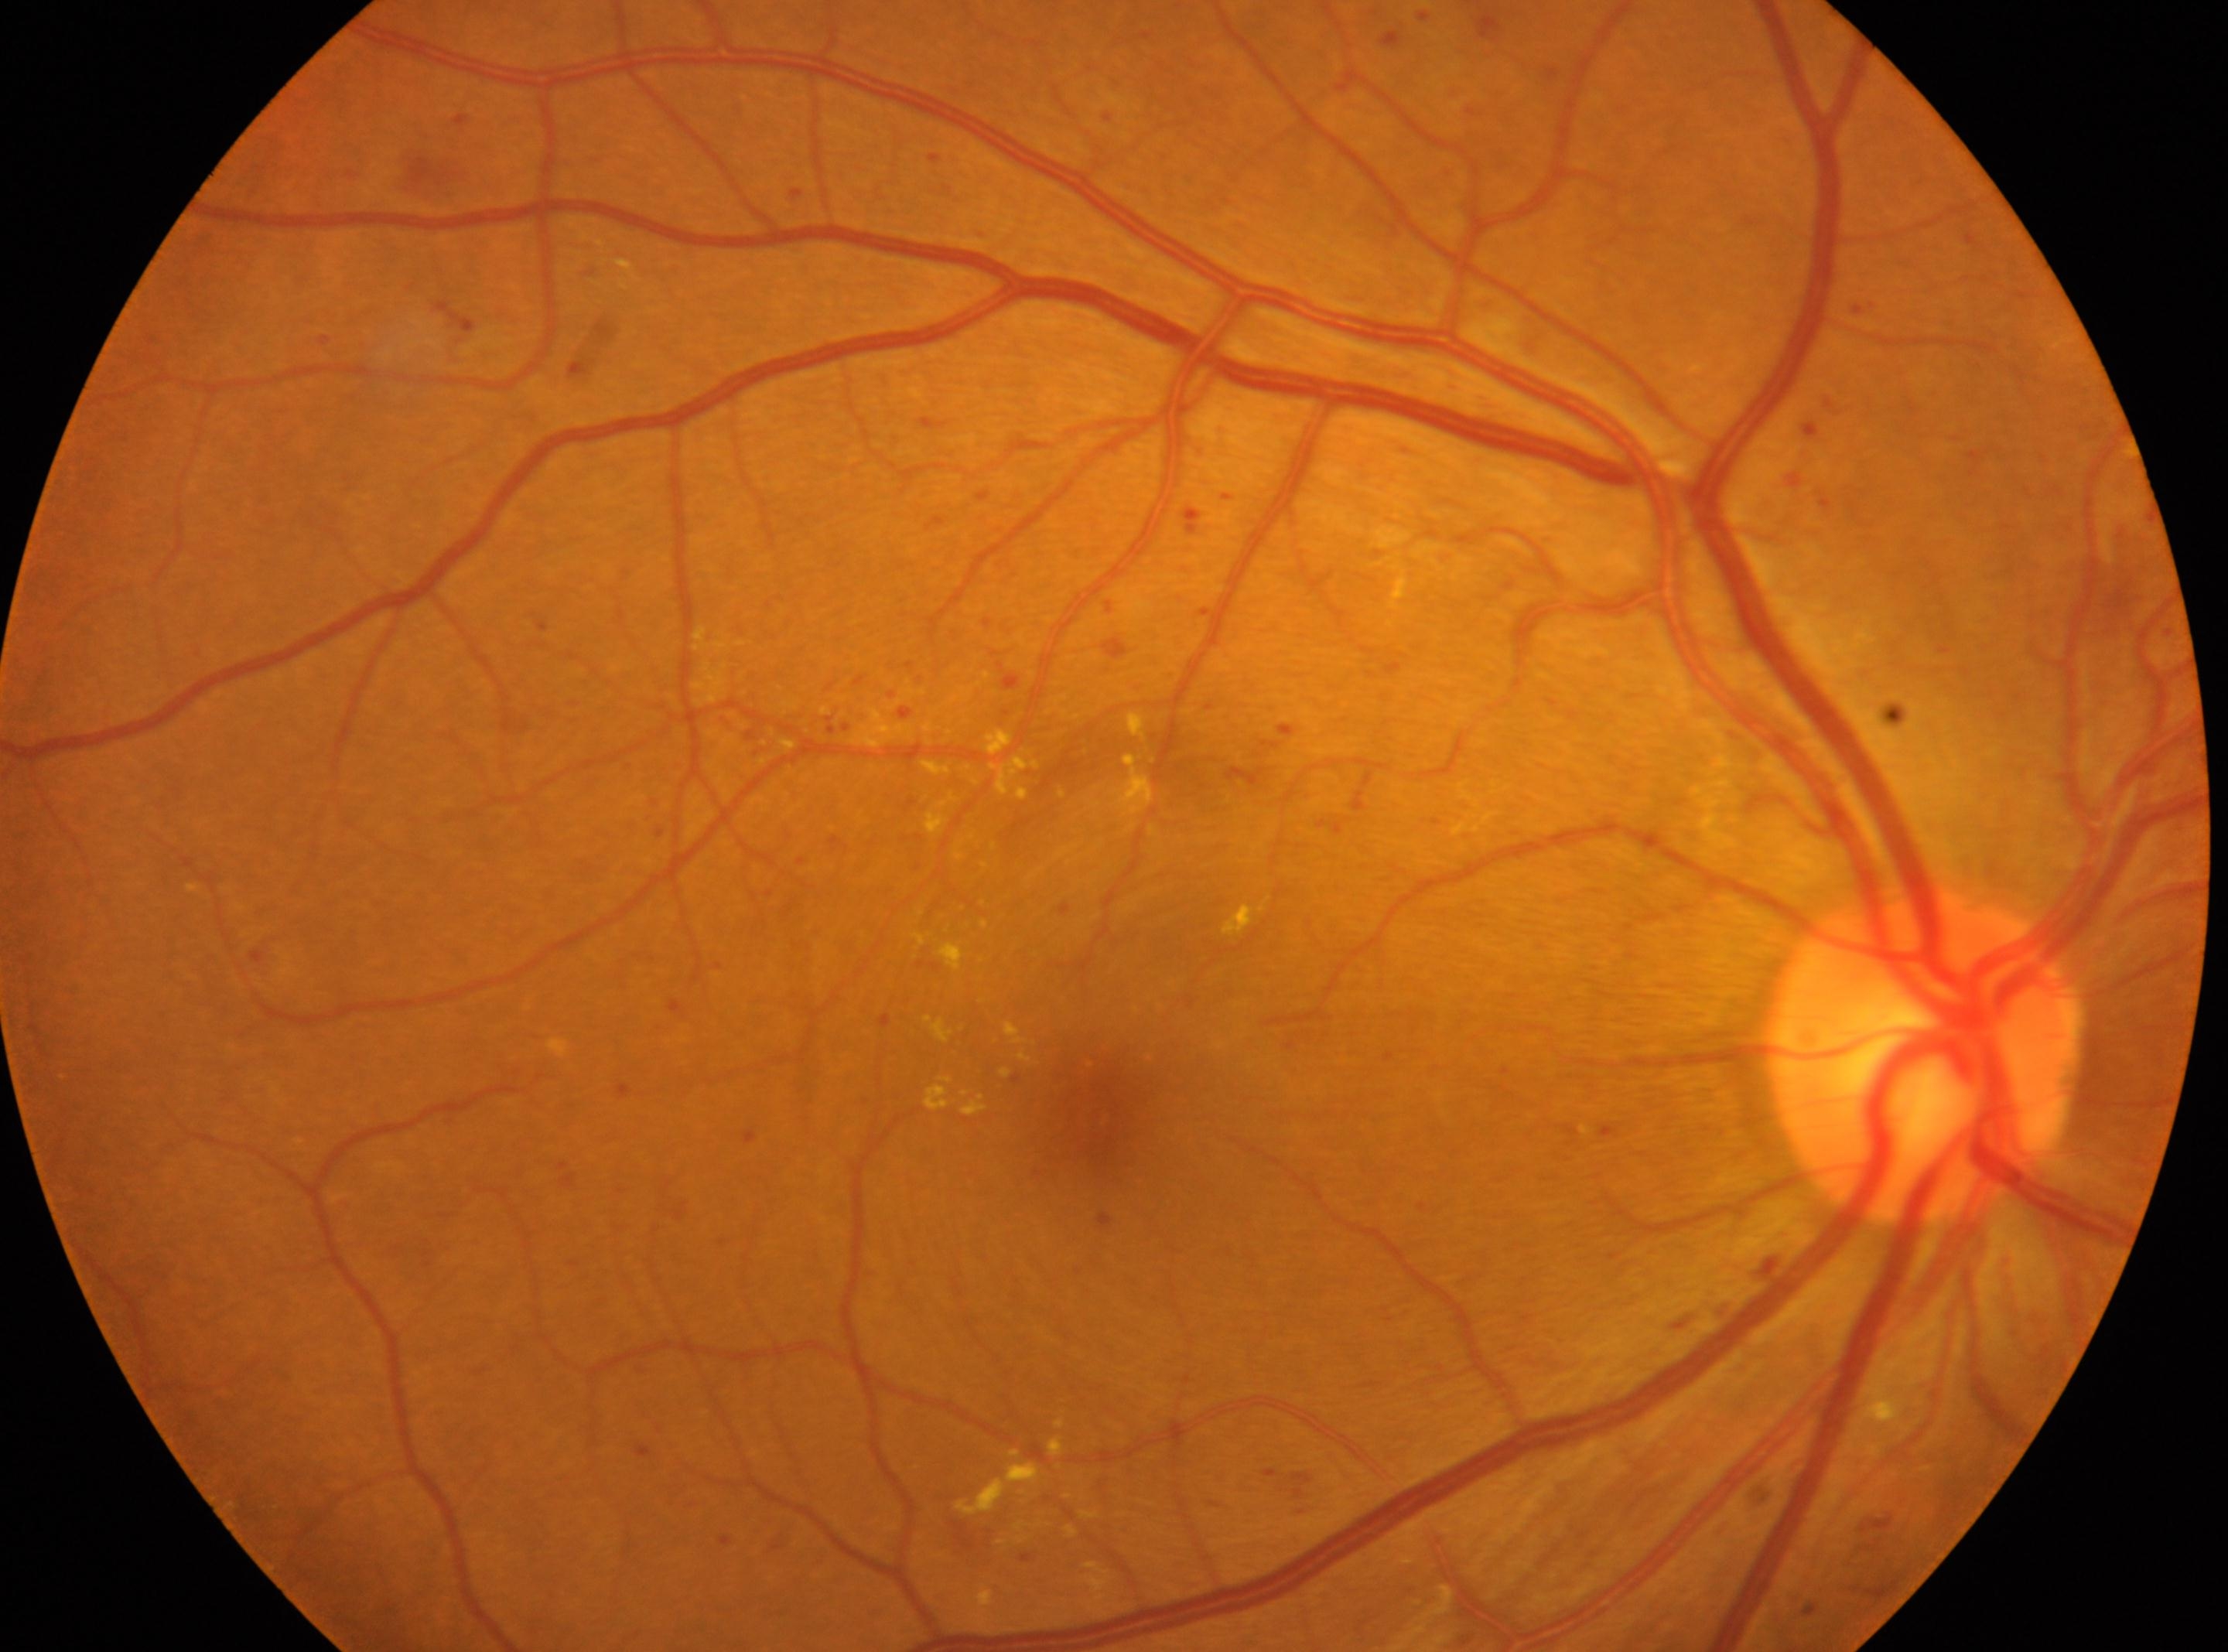 non-proliferative diabetic retinopathy | ONH=1920, 1056 | OD | DR=moderate NPDR (grade 2) | the fovea=1097, 1117.